Wide-field fundus photograph of an infant — 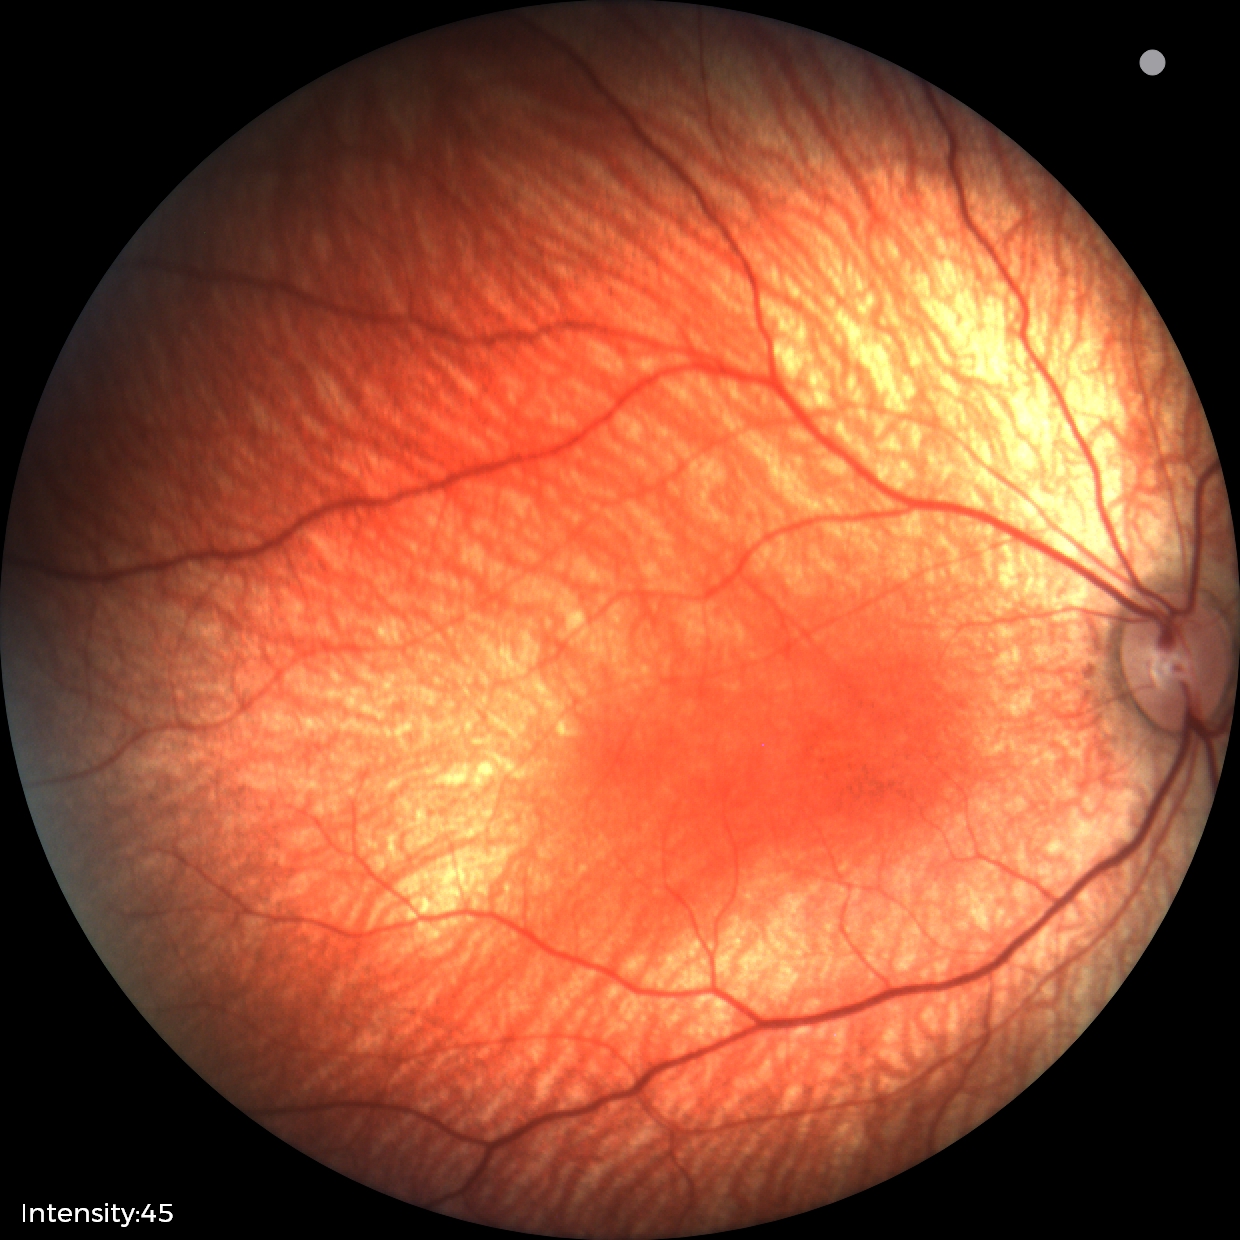 No retinal pathology identified on screening.